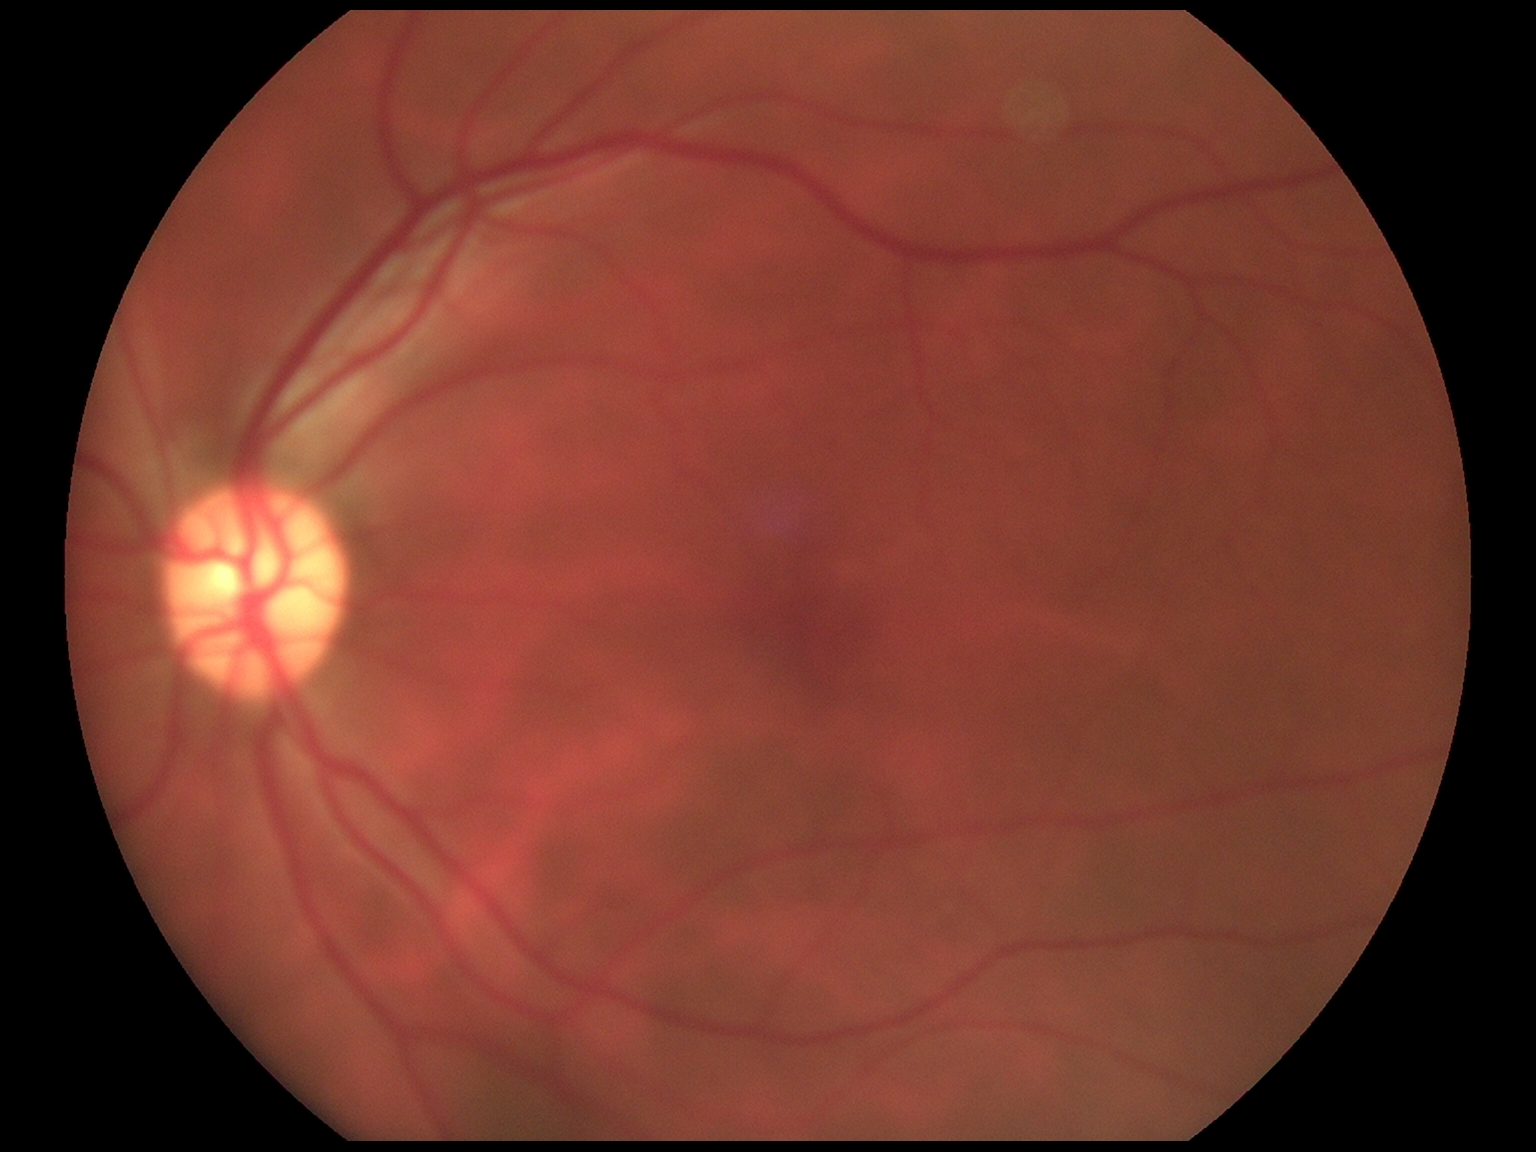
DR stage is grade 0 (no apparent retinopathy).